Axial length (AL) 22.76 mm; woman; refractive error: -3 -0.75 x 10; intraocular pressure: 16 mmHg — 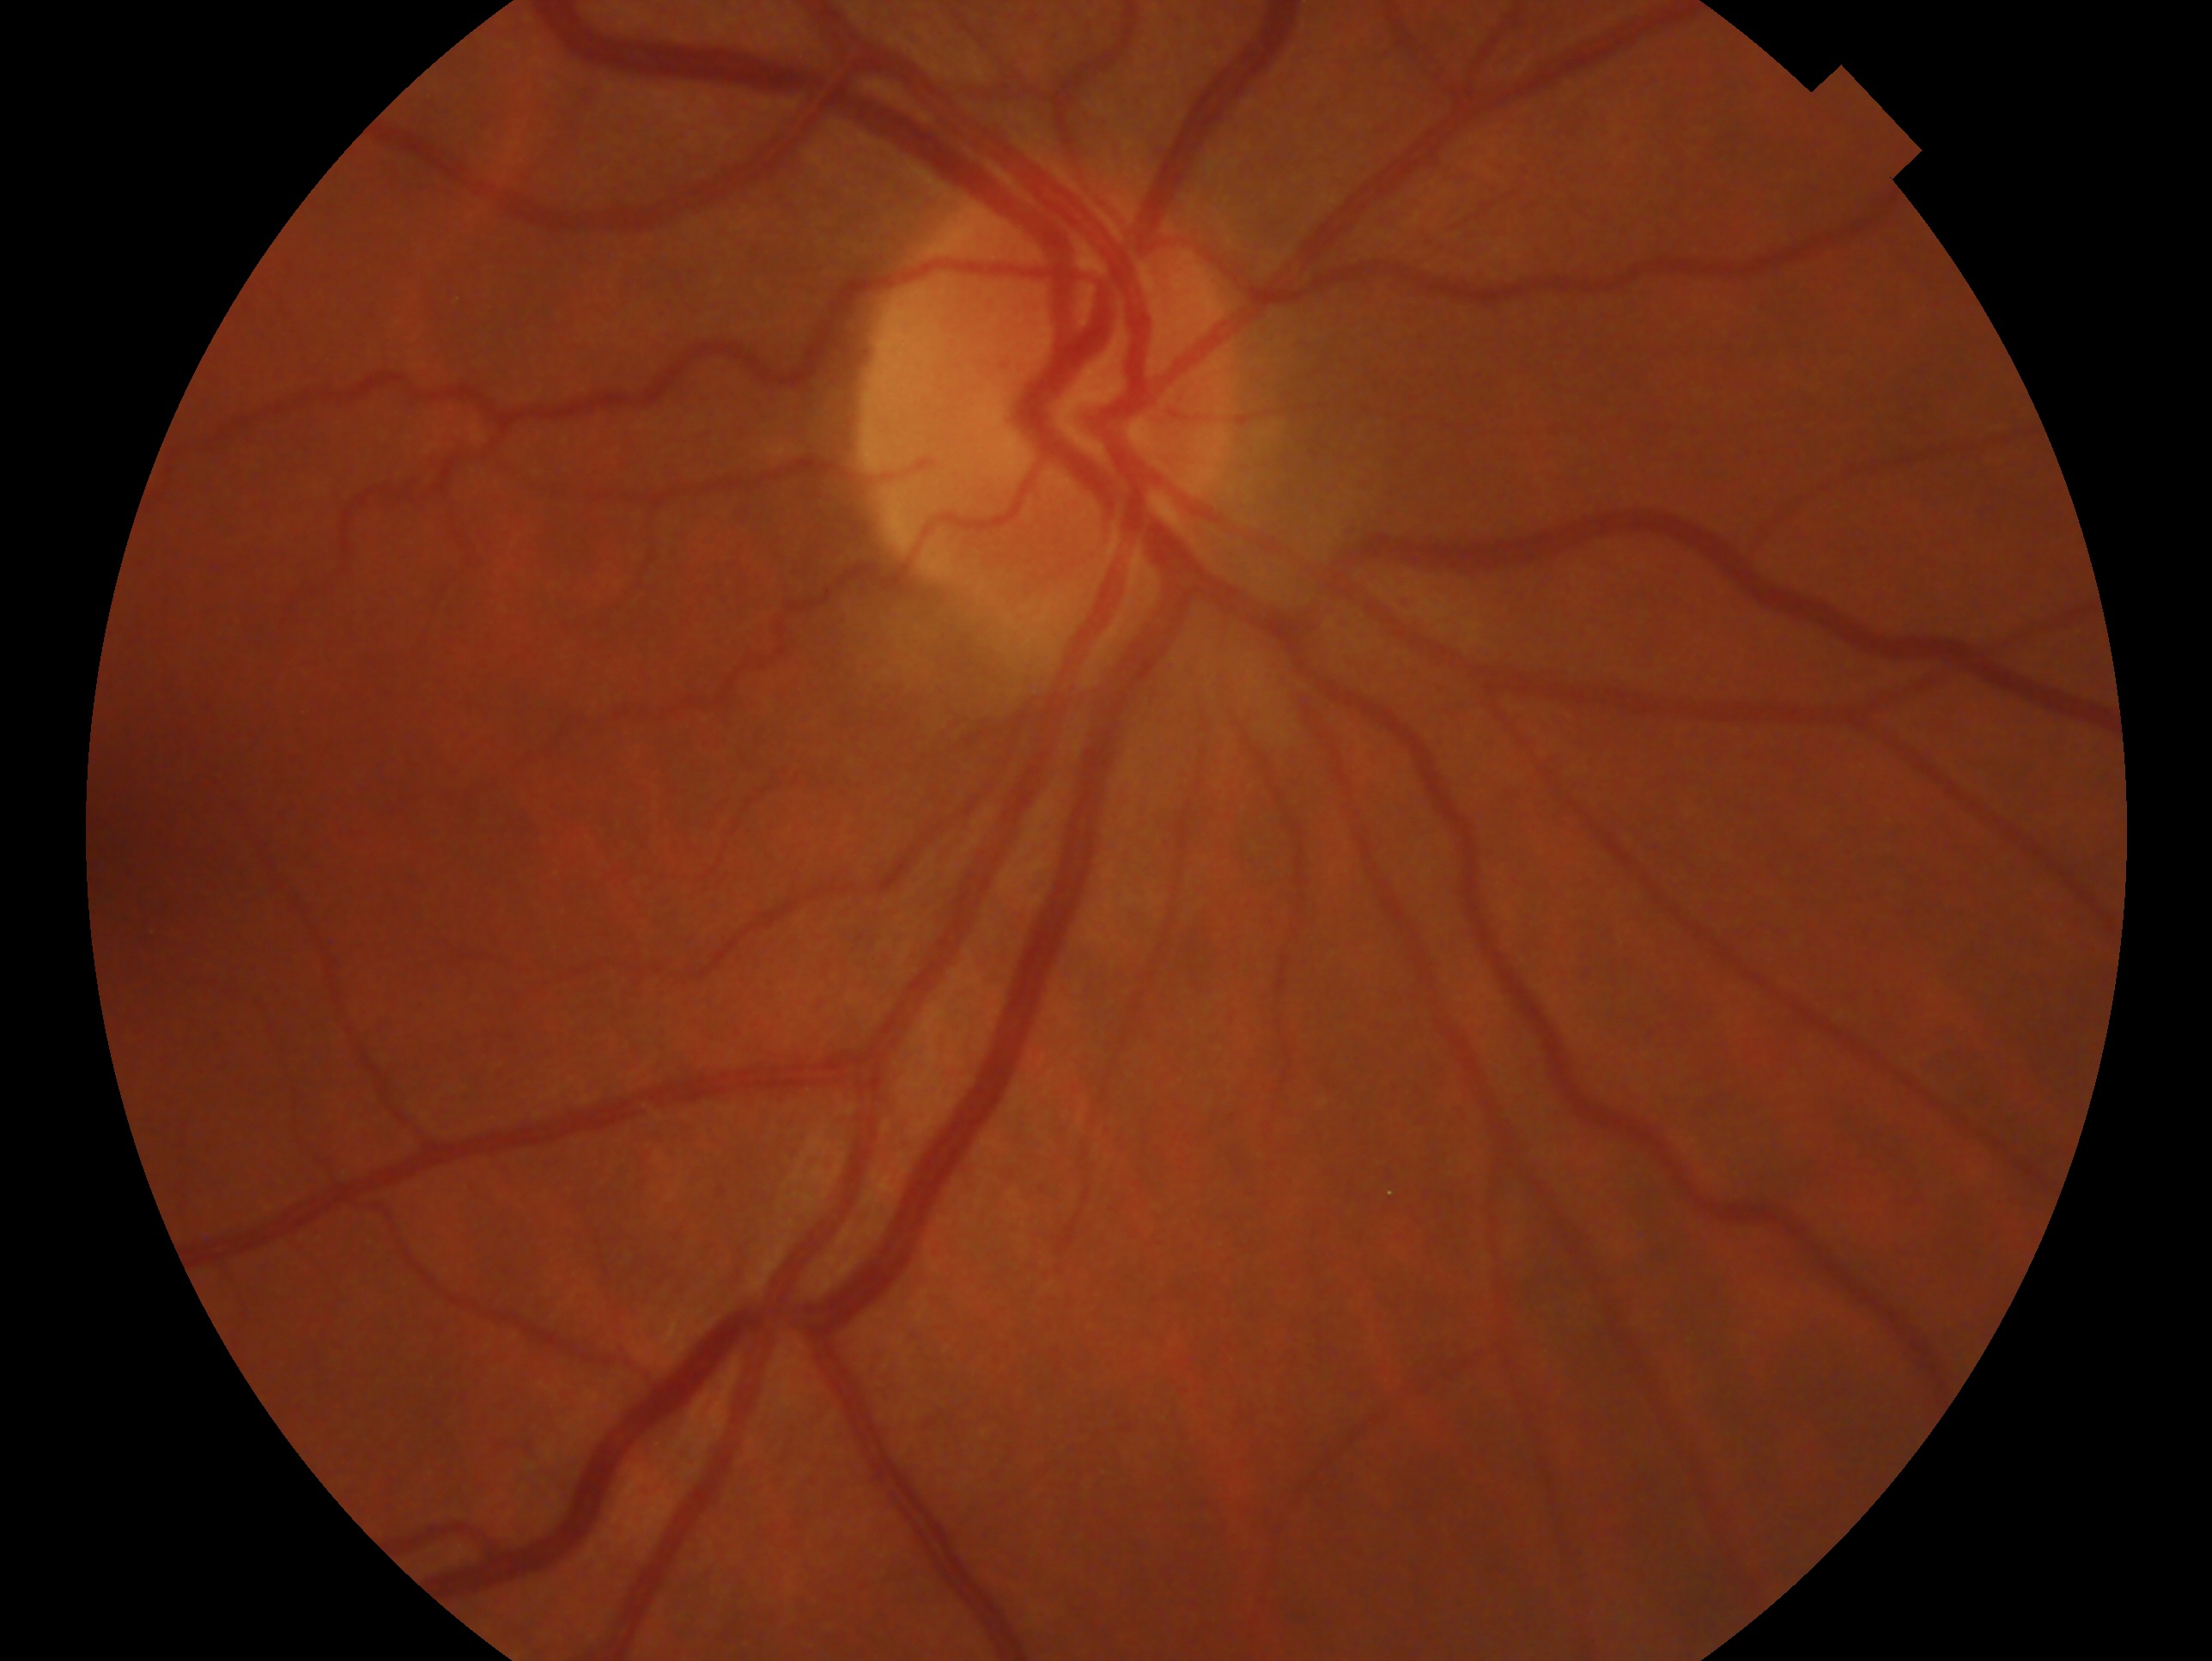

diagnosis: no signs of glaucoma, eye: OD.